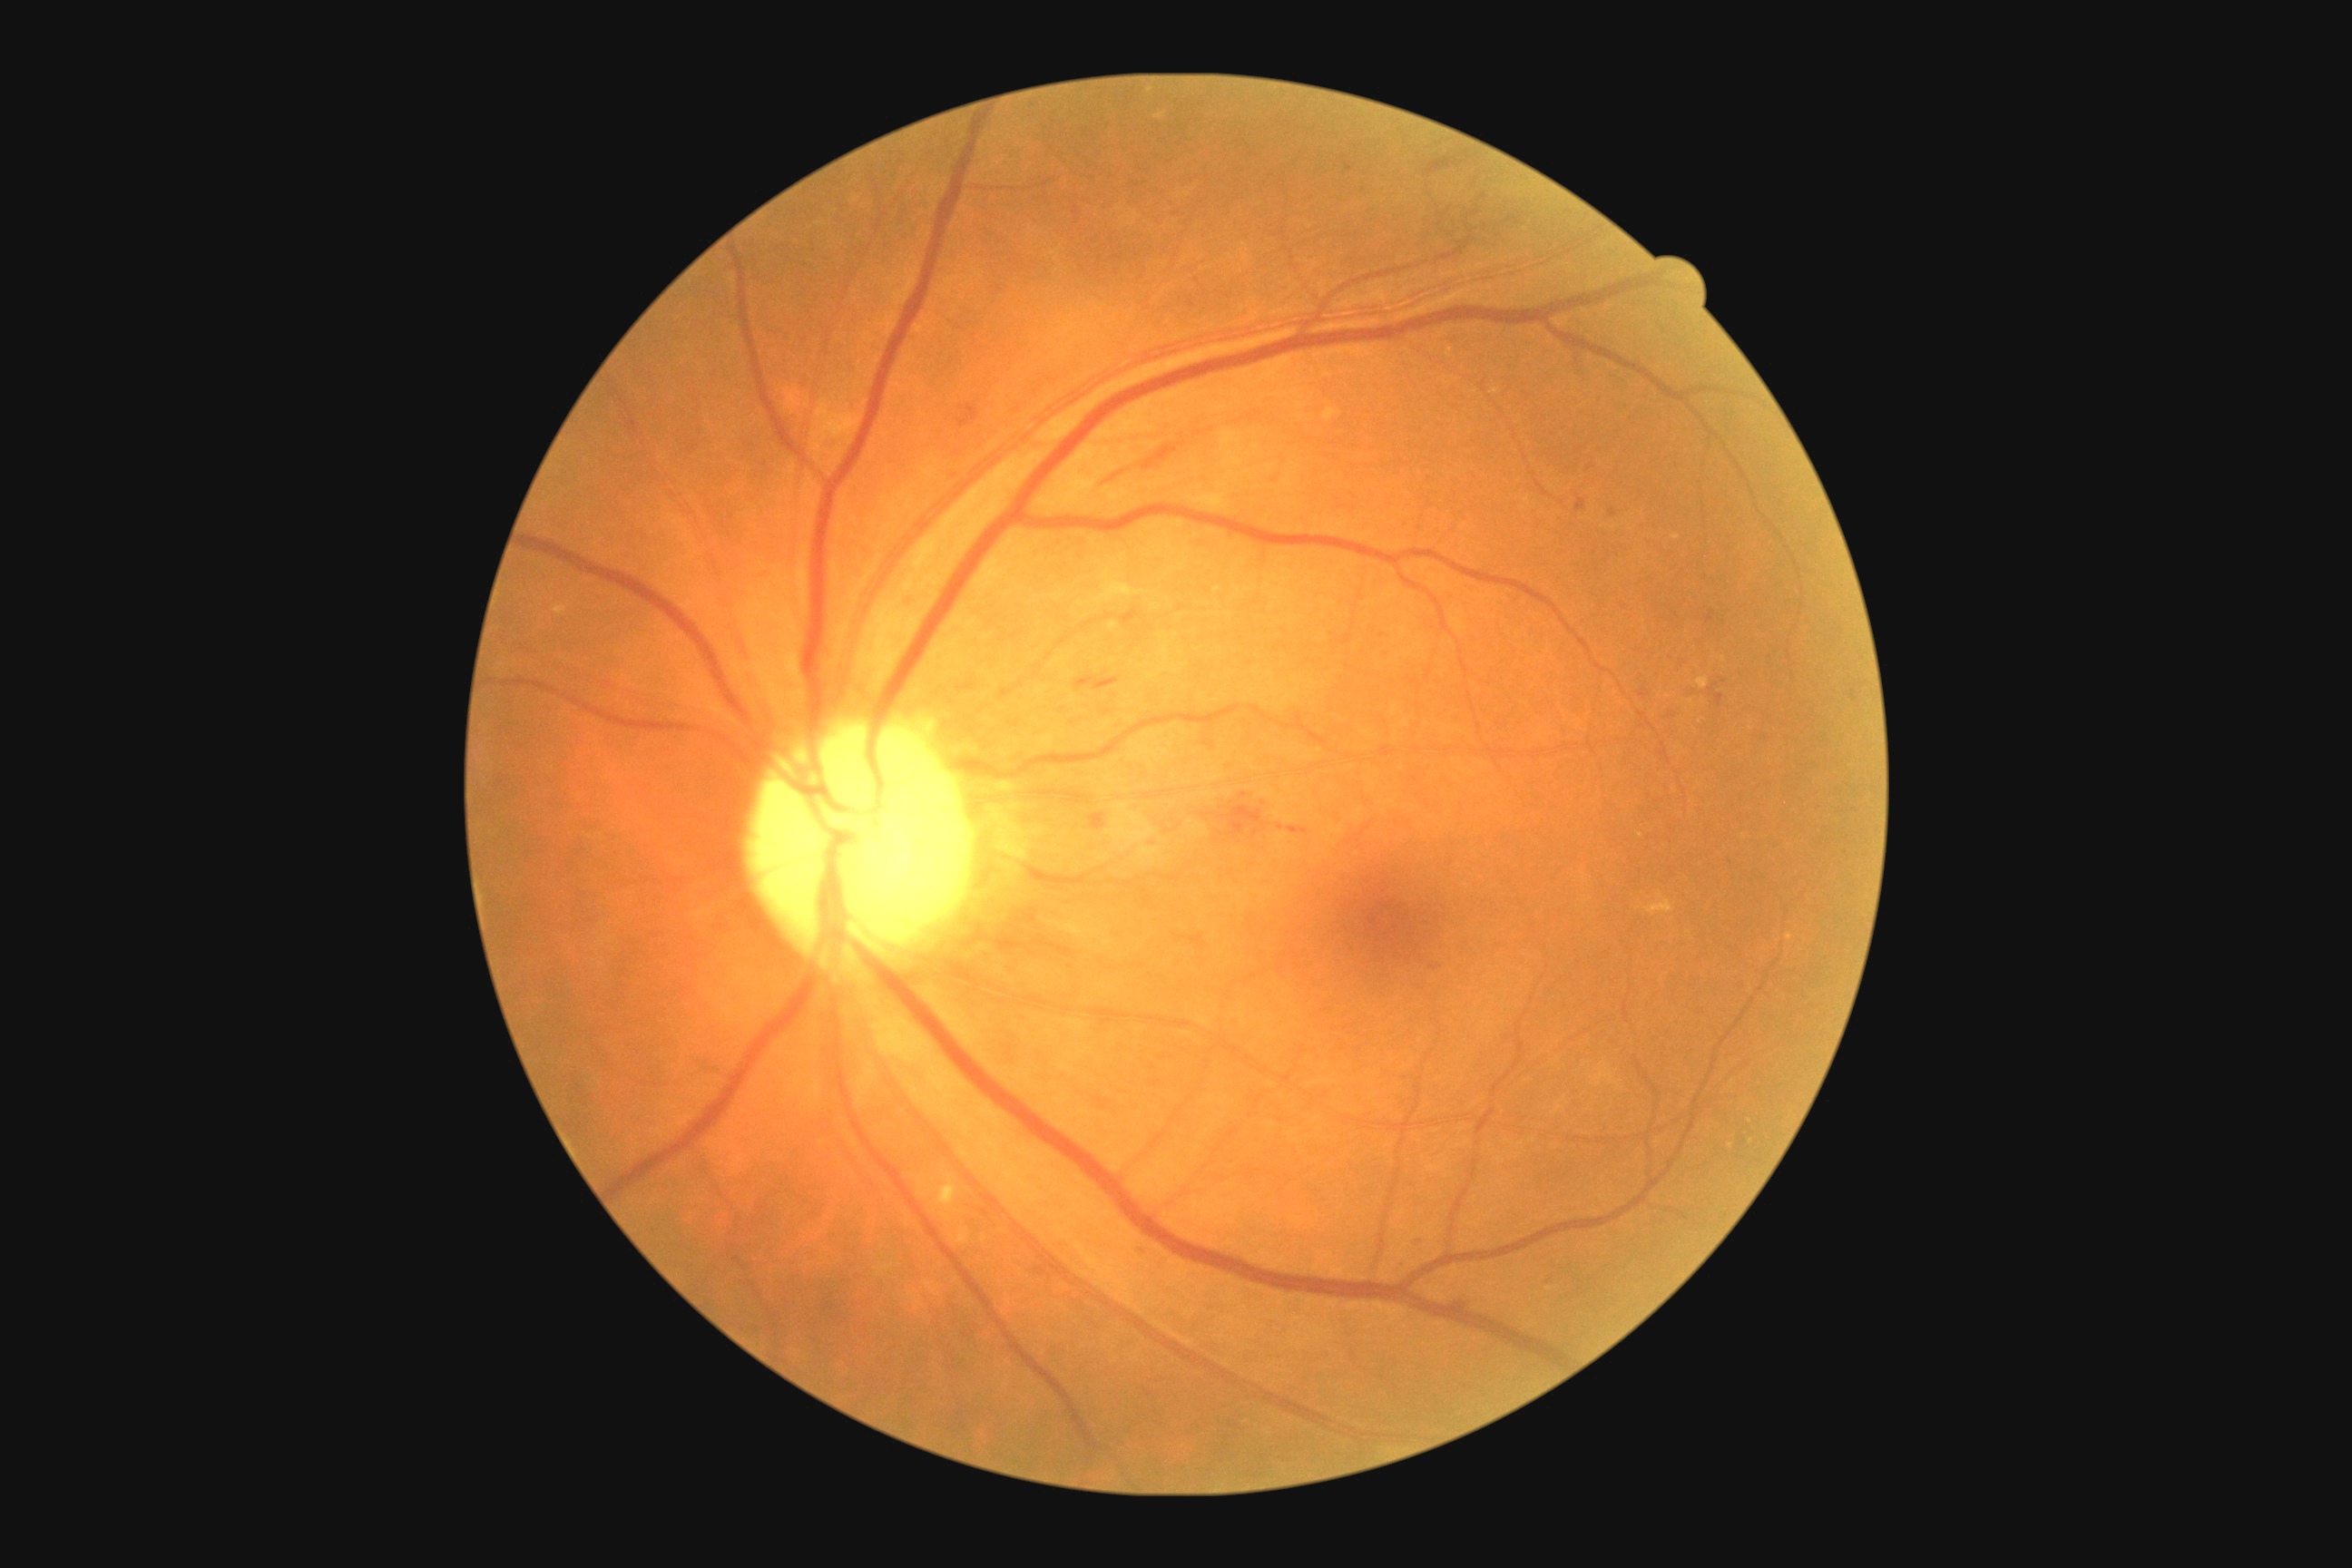
DR severity: moderate non-proliferative diabetic retinopathy (grade 2).